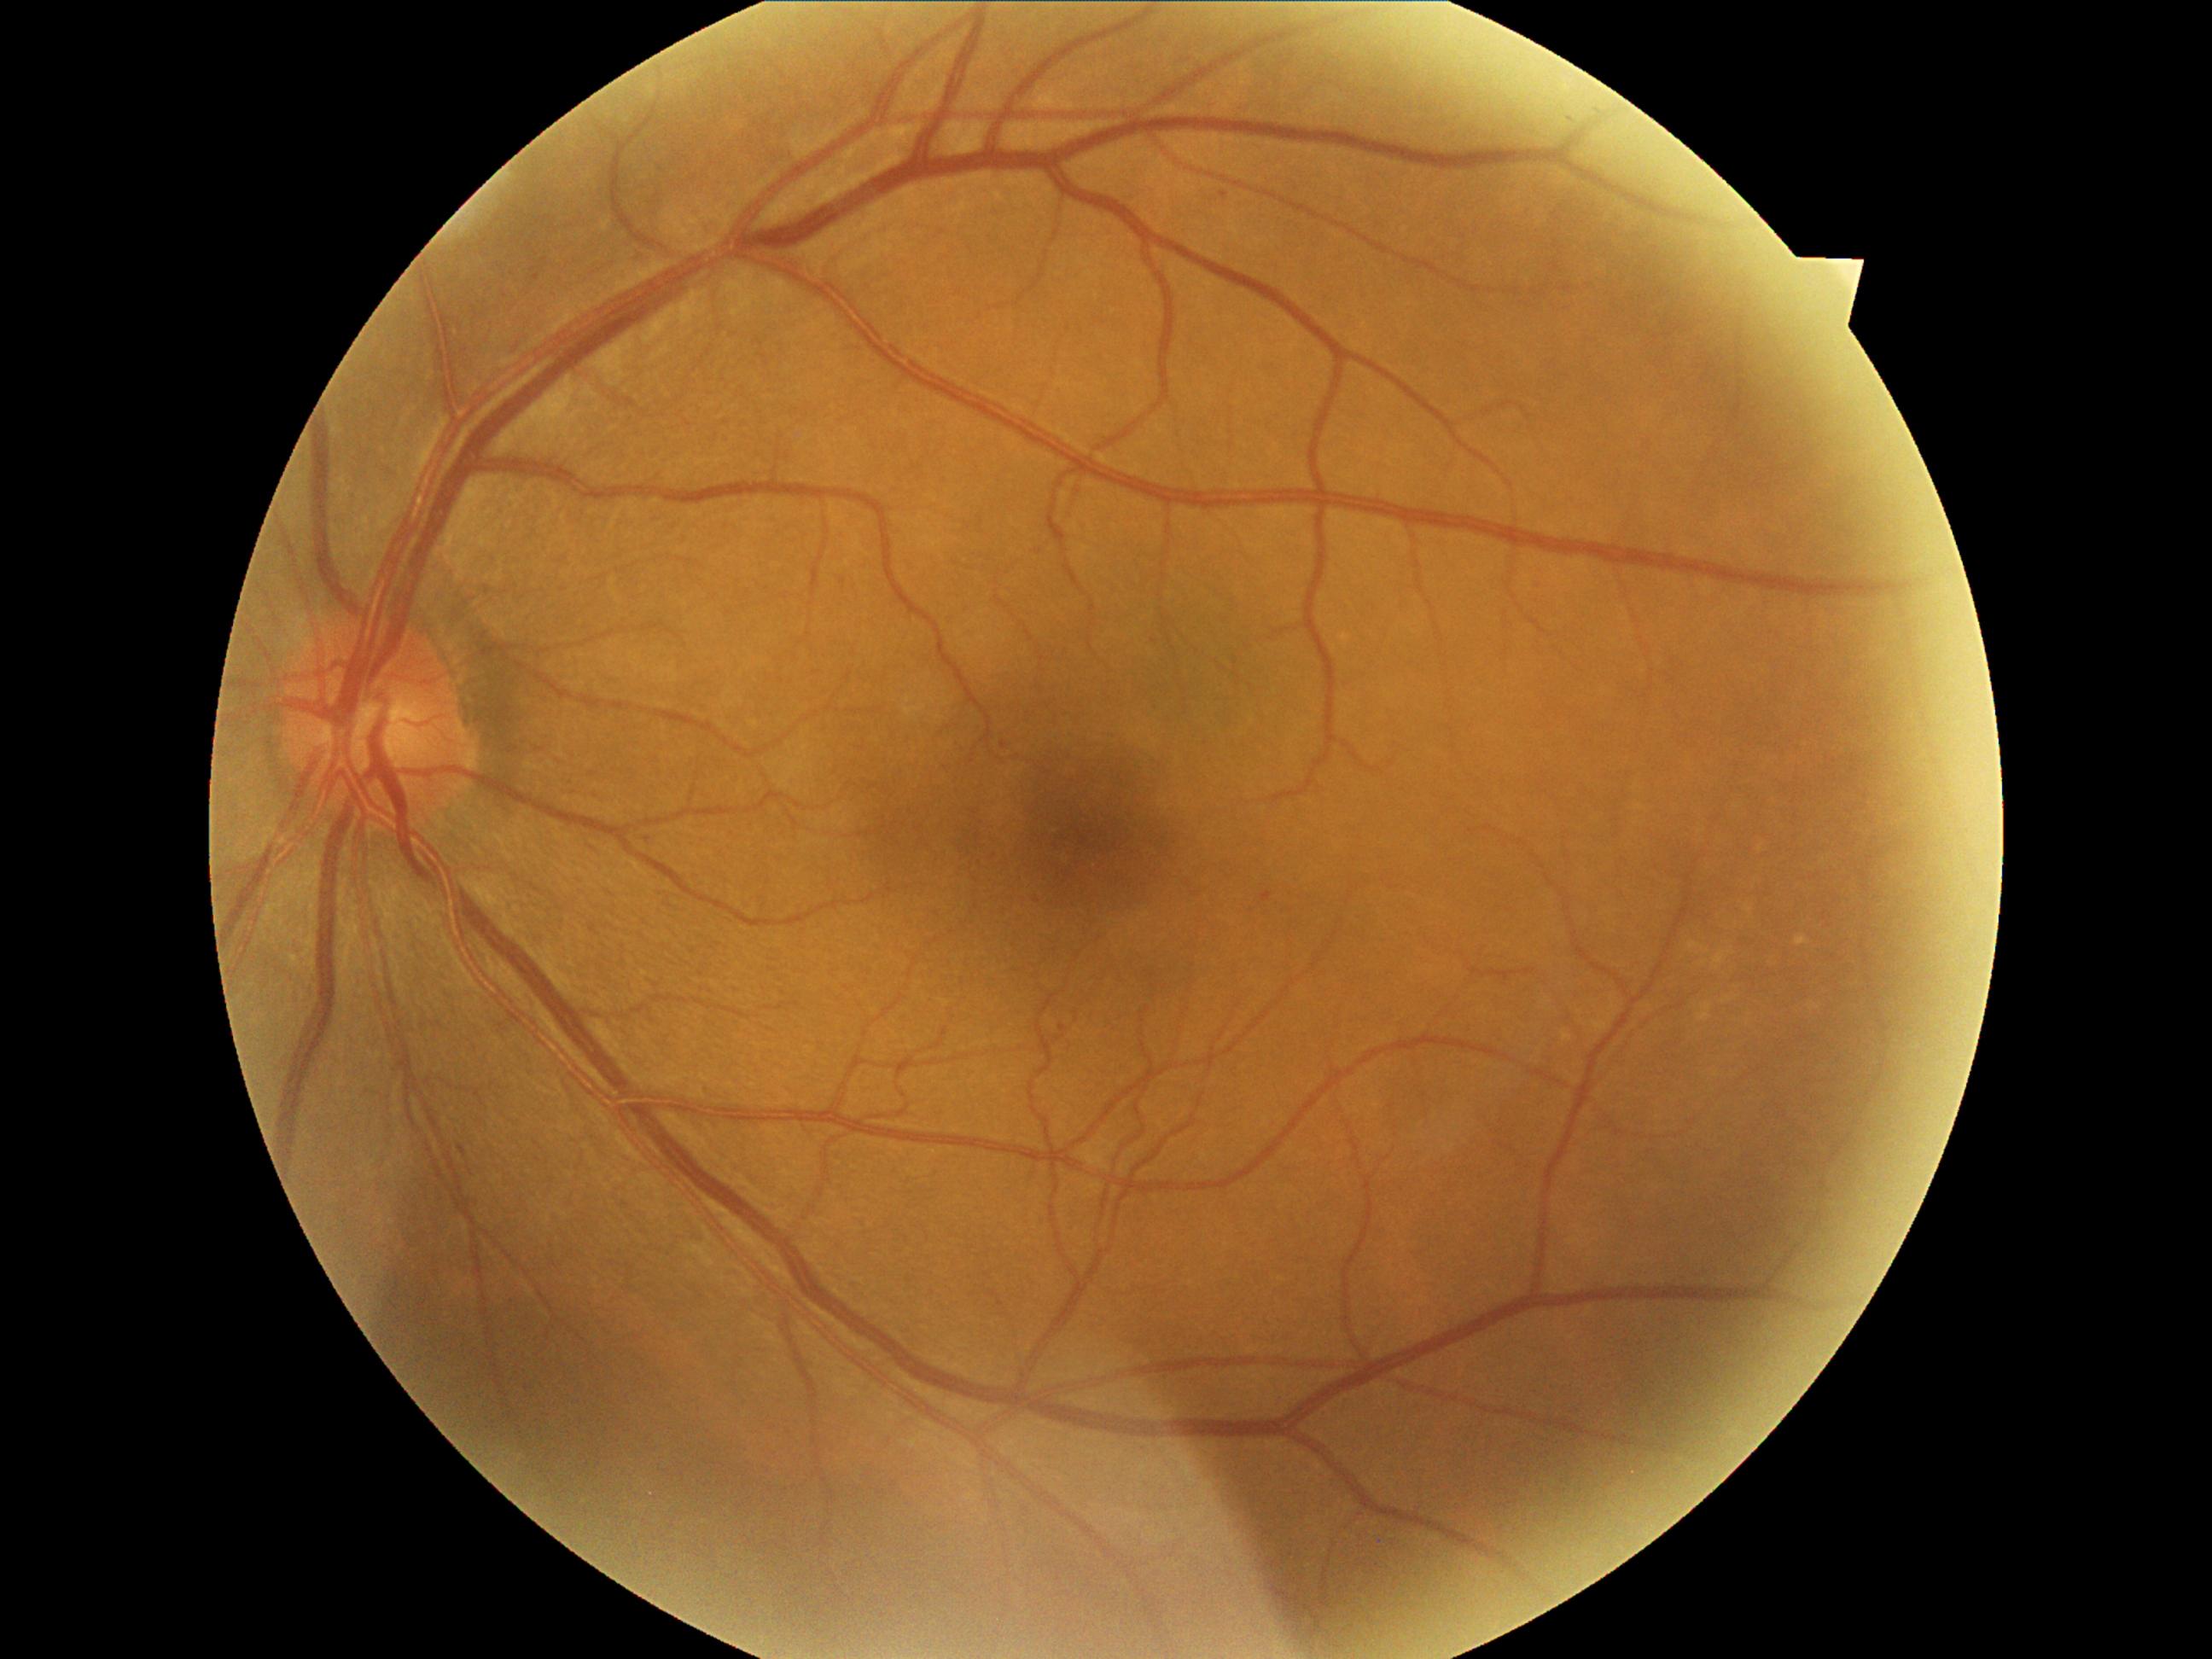 DR stage = grade 1 (mild NPDR) — presence of microaneurysms only